Graded on the modified Davis scale:
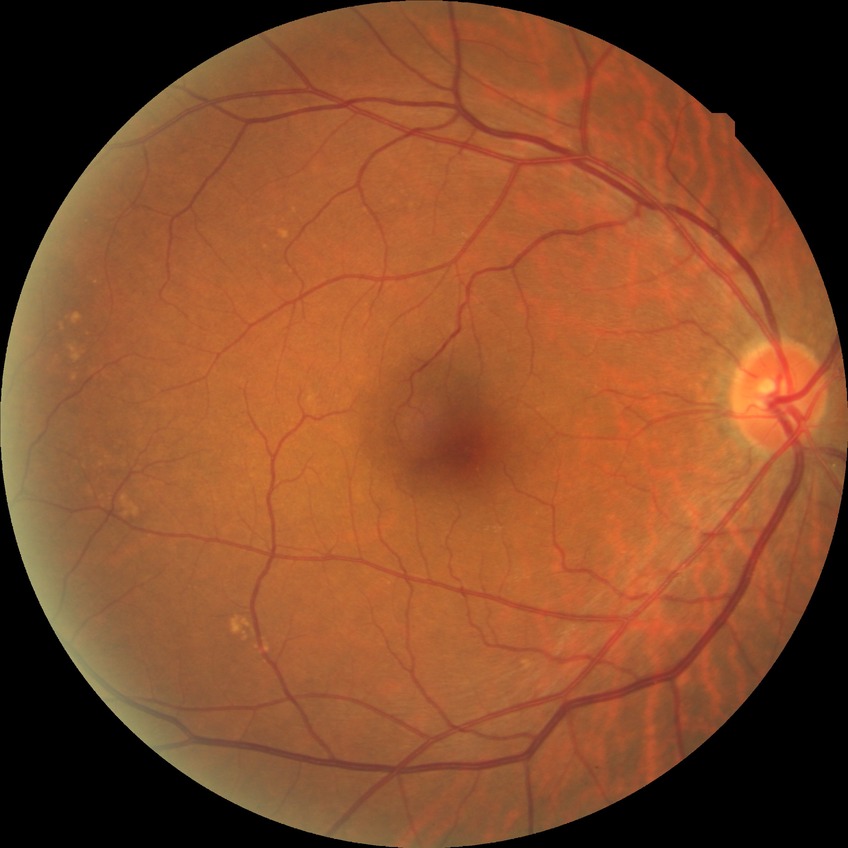

Diabetic retinopathy (DR): NDR (no diabetic retinopathy).